1240x1240px; Phoenix ICON wide-field infant fundus image; acquired on the Phoenix ICON: 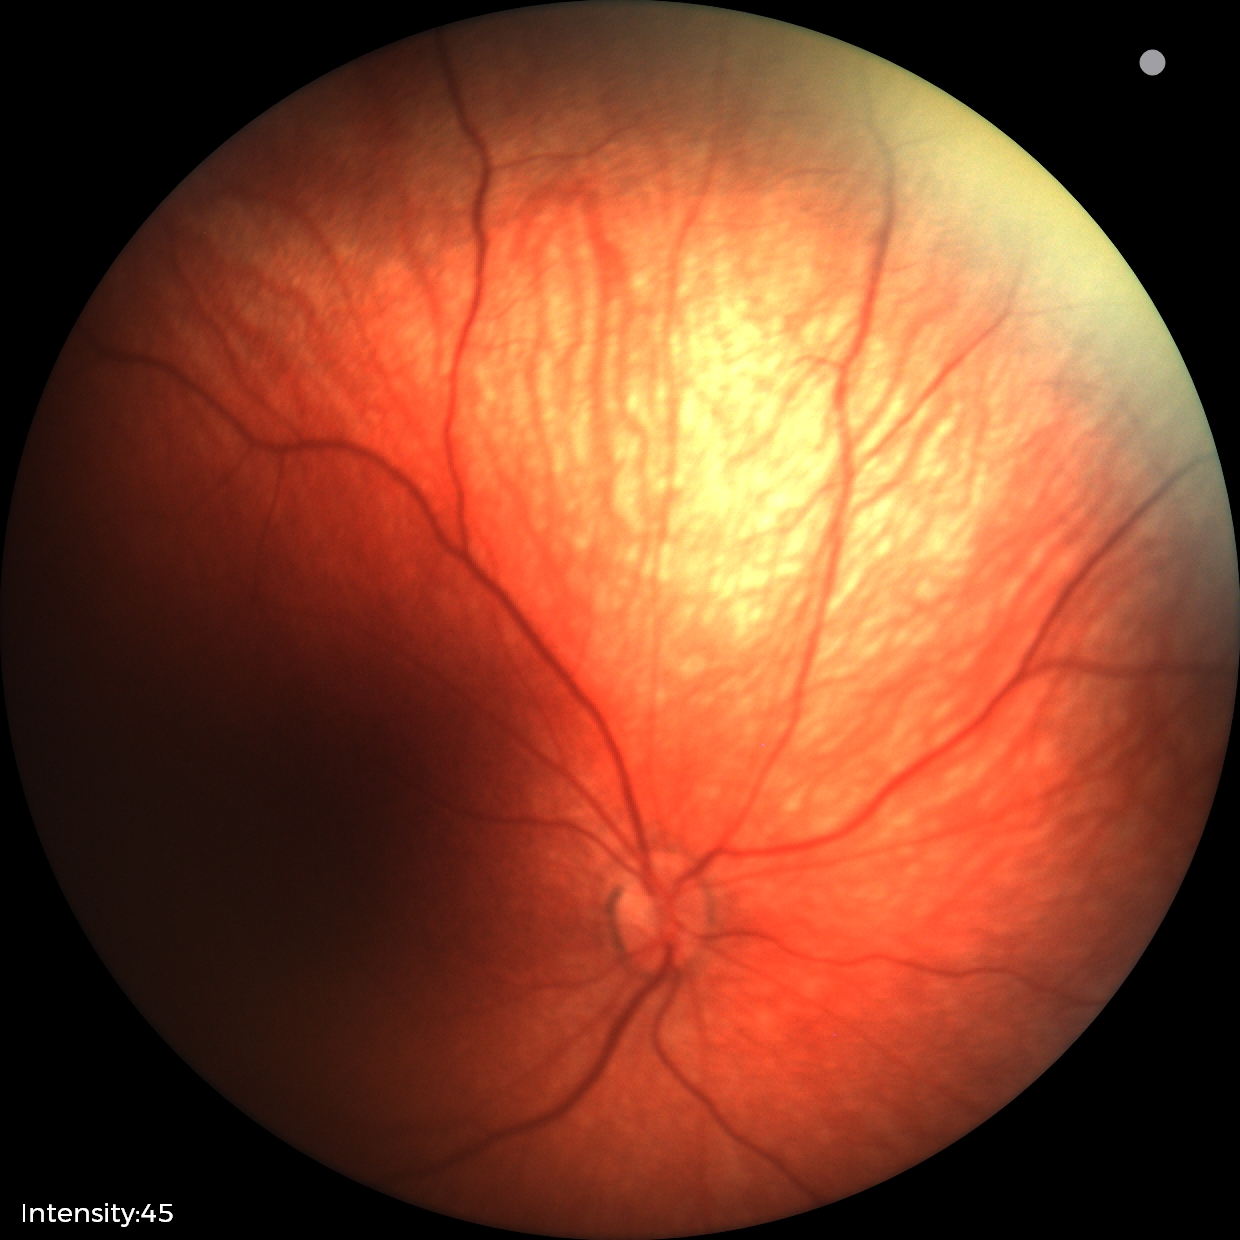 Screening examination diagnosed as physiological.